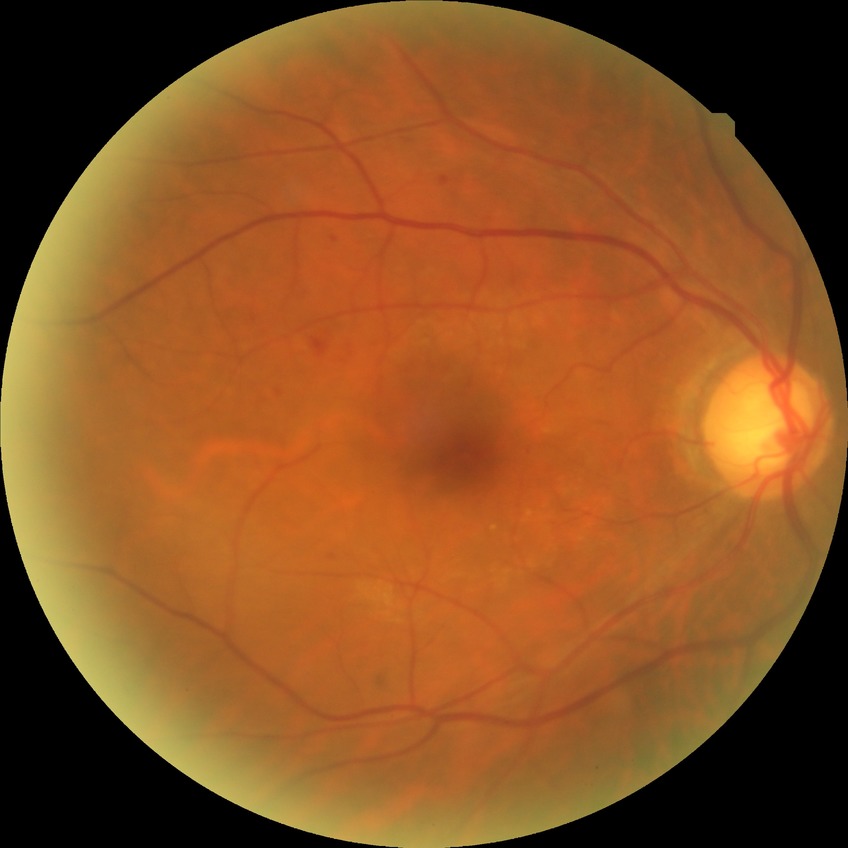
Diabetic retinopathy severity: simple diabetic retinopathy.